Diabetic retinopathy graded by the modified Davis classification. No pharmacologic dilation: 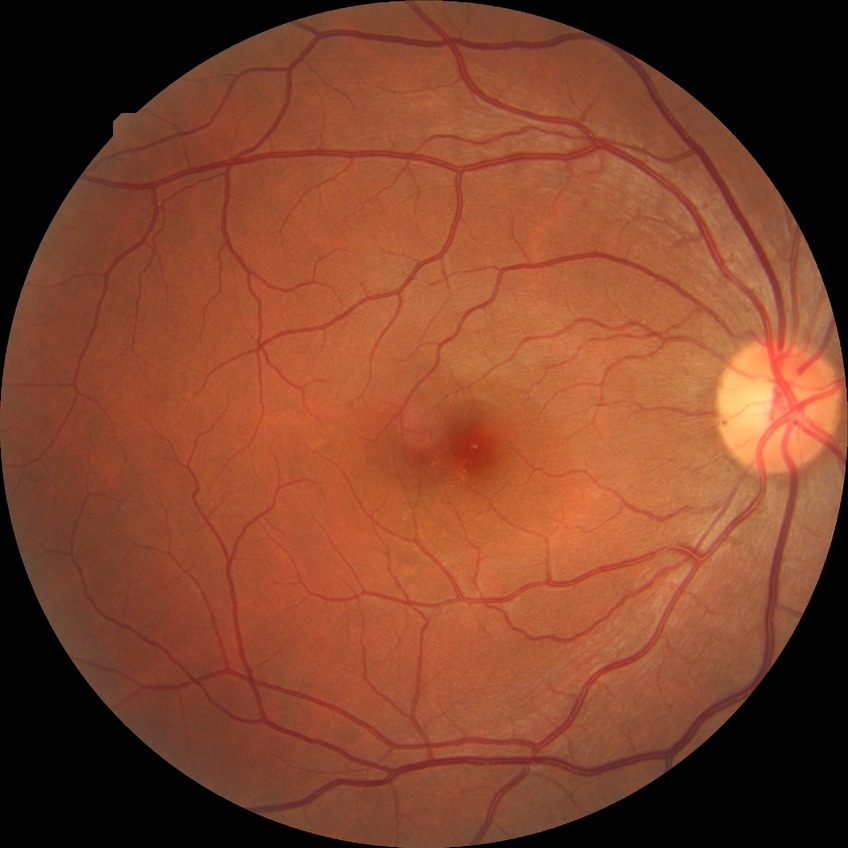
Diabetic retinopathy stage: no diabetic retinopathy.